Macula-centered field, 2361x1568, FOV: 50 degrees, fundus photo.
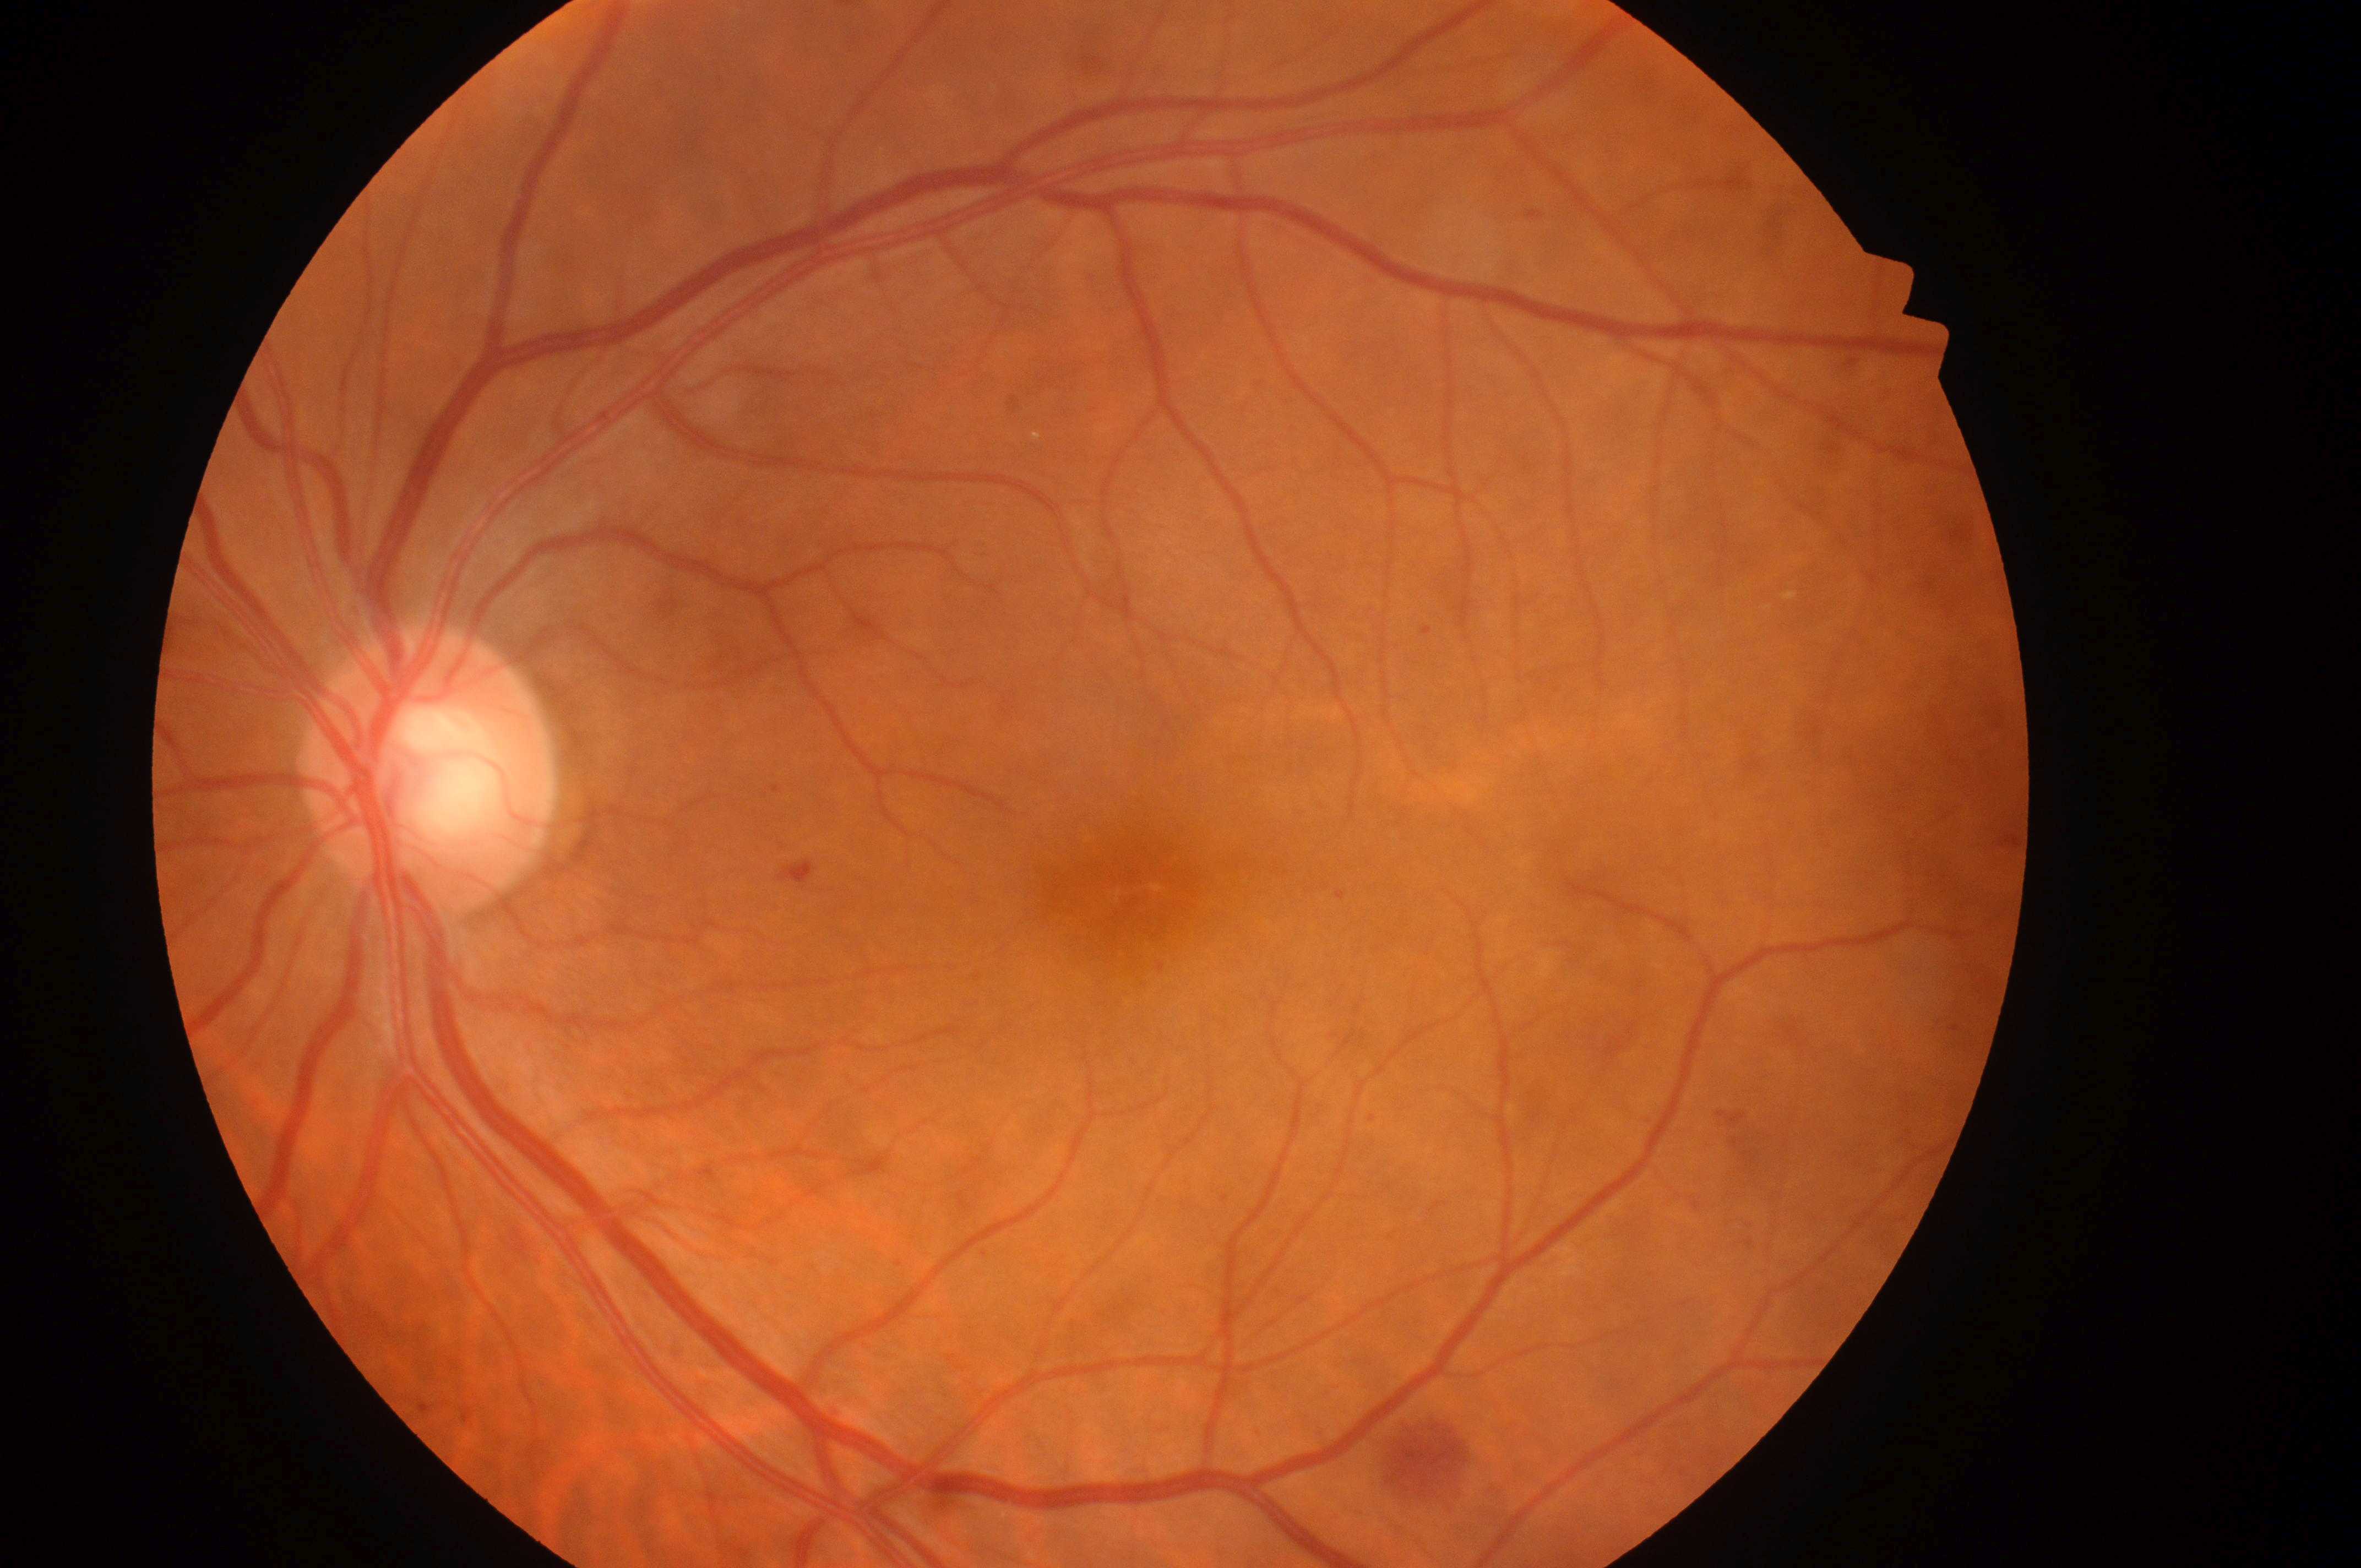
fovea: 1132, 899
optic_disc: 422, 783
dme_grade: 1/2
eye: left
dr_category: non-proliferative diabetic retinopathy
dr_grade: 2